DR severity per modified Davis staging · posterior pole color fundus photograph · nonmydriatic: 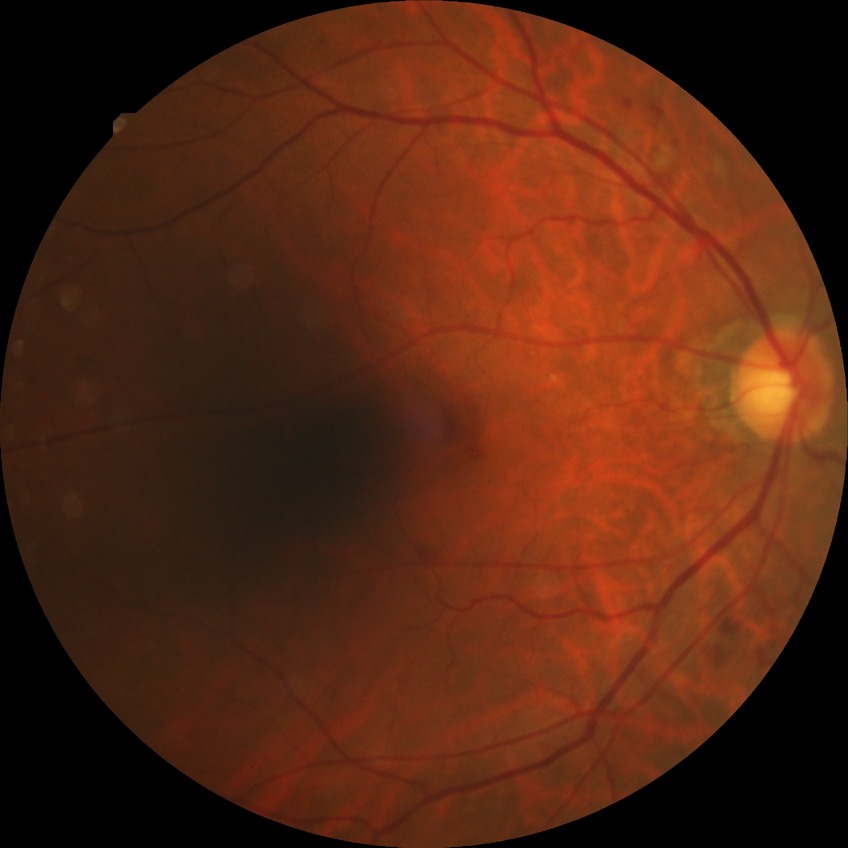
Findings:
• DR class: non-proliferative diabetic retinopathy
• DR severity: SDR